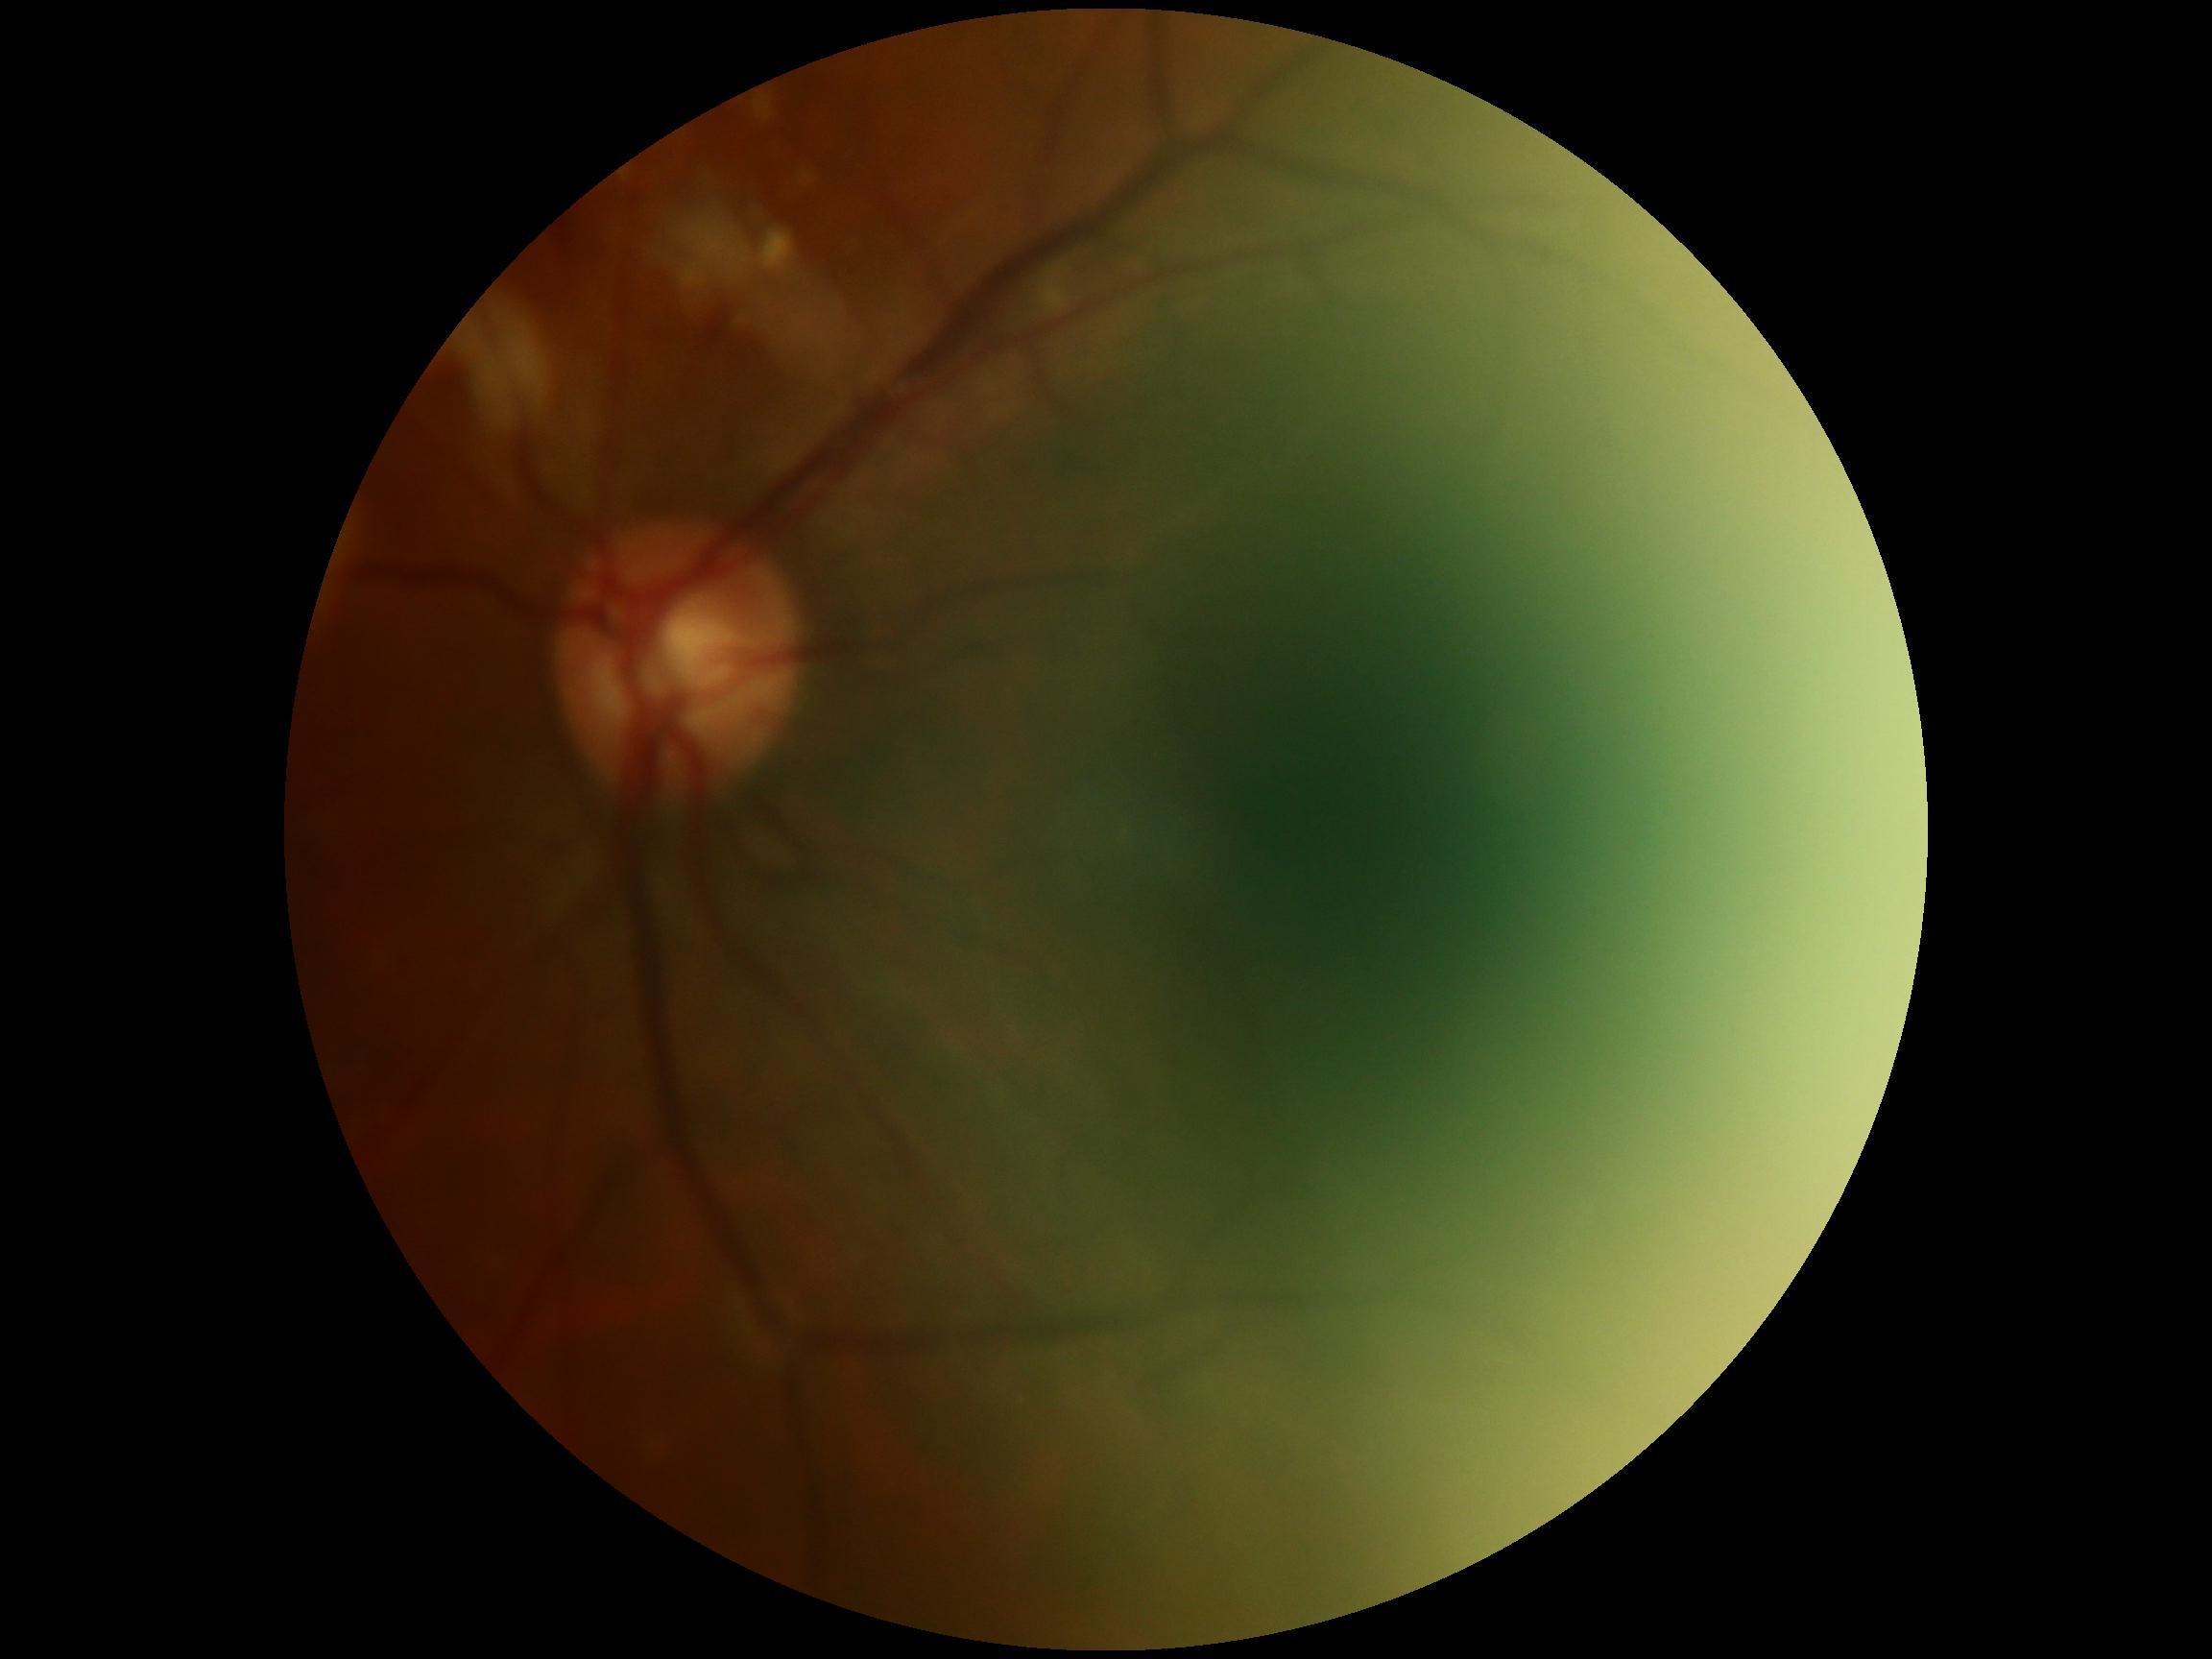
Diabetic retinopathy (DR): ungradable due to poor image quality.